Acquired on the Clarity RetCam 3; wide-field contact fundus photograph of an infant; 640x480.
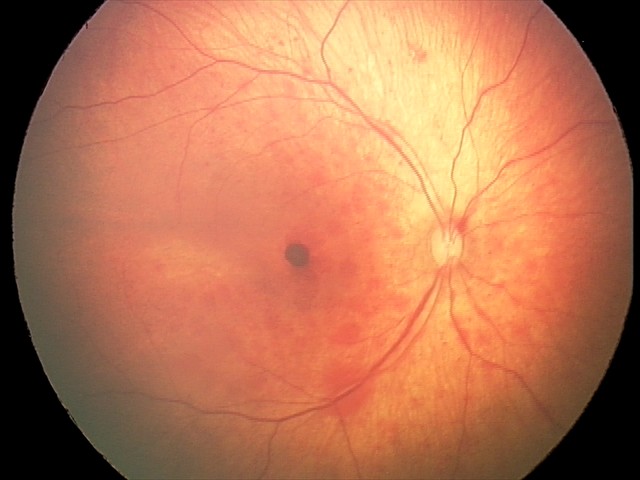 Series diagnosed as retinal hemorrhages.